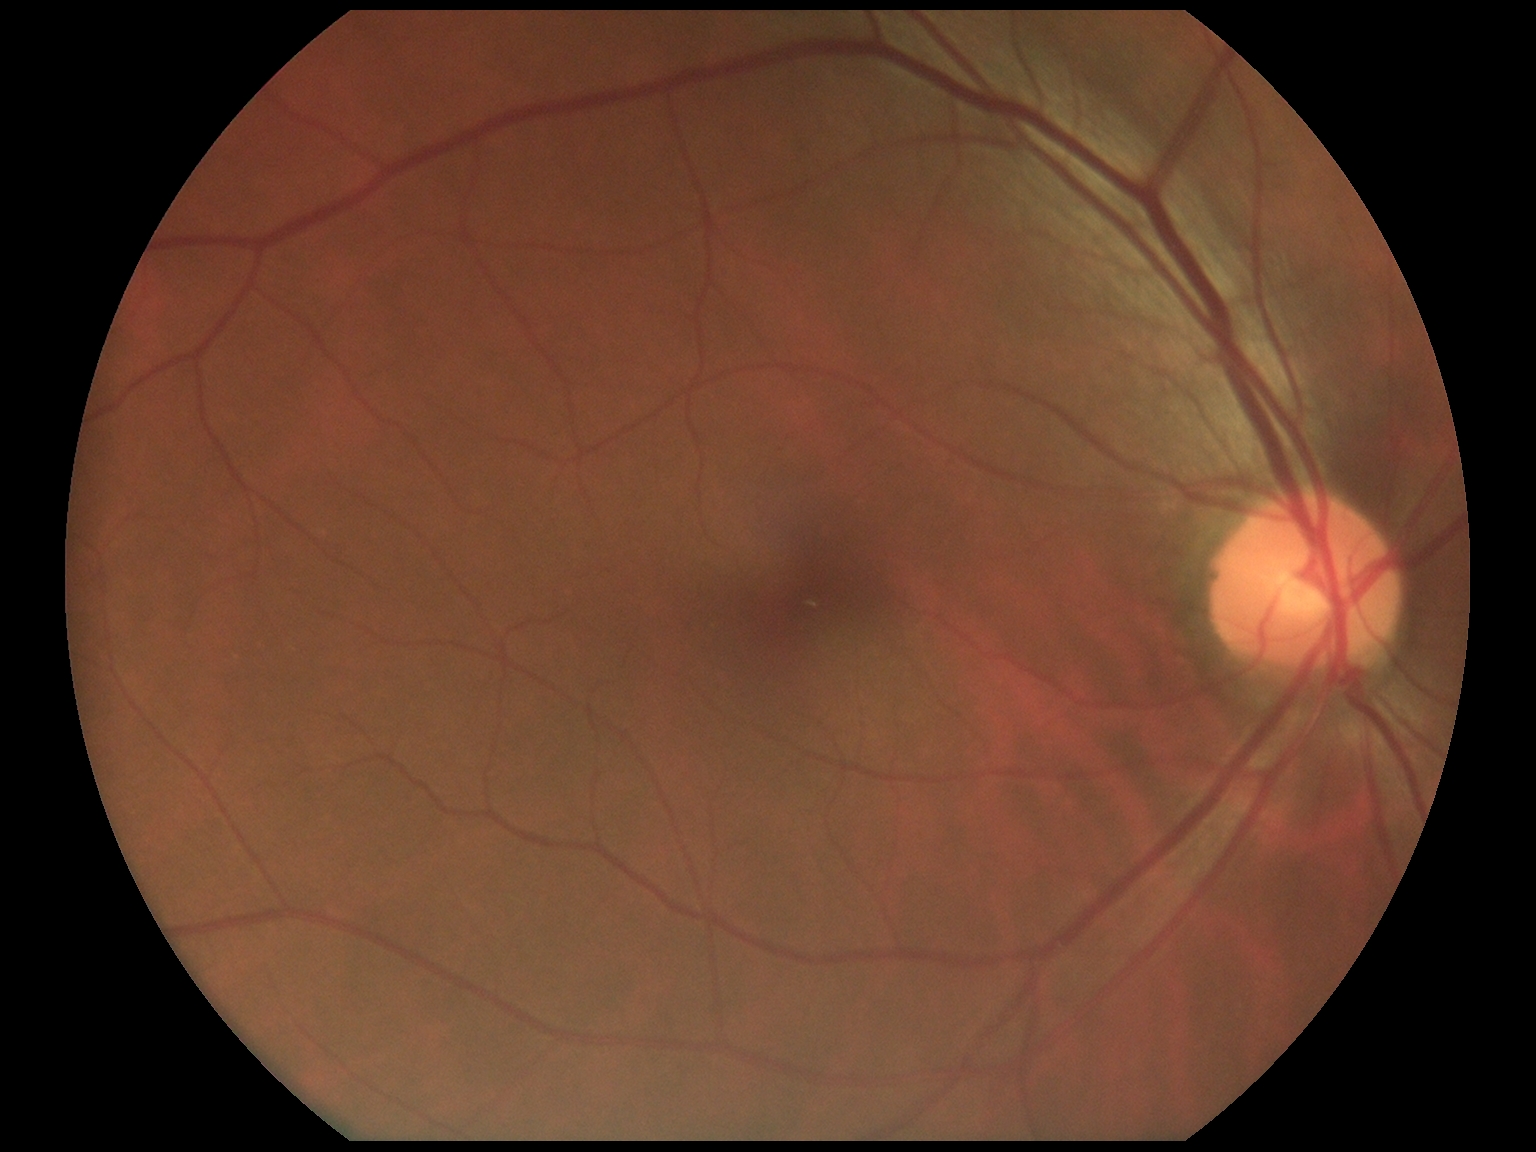

Diabetic retinopathy (DR): grade 0 (no apparent retinopathy).